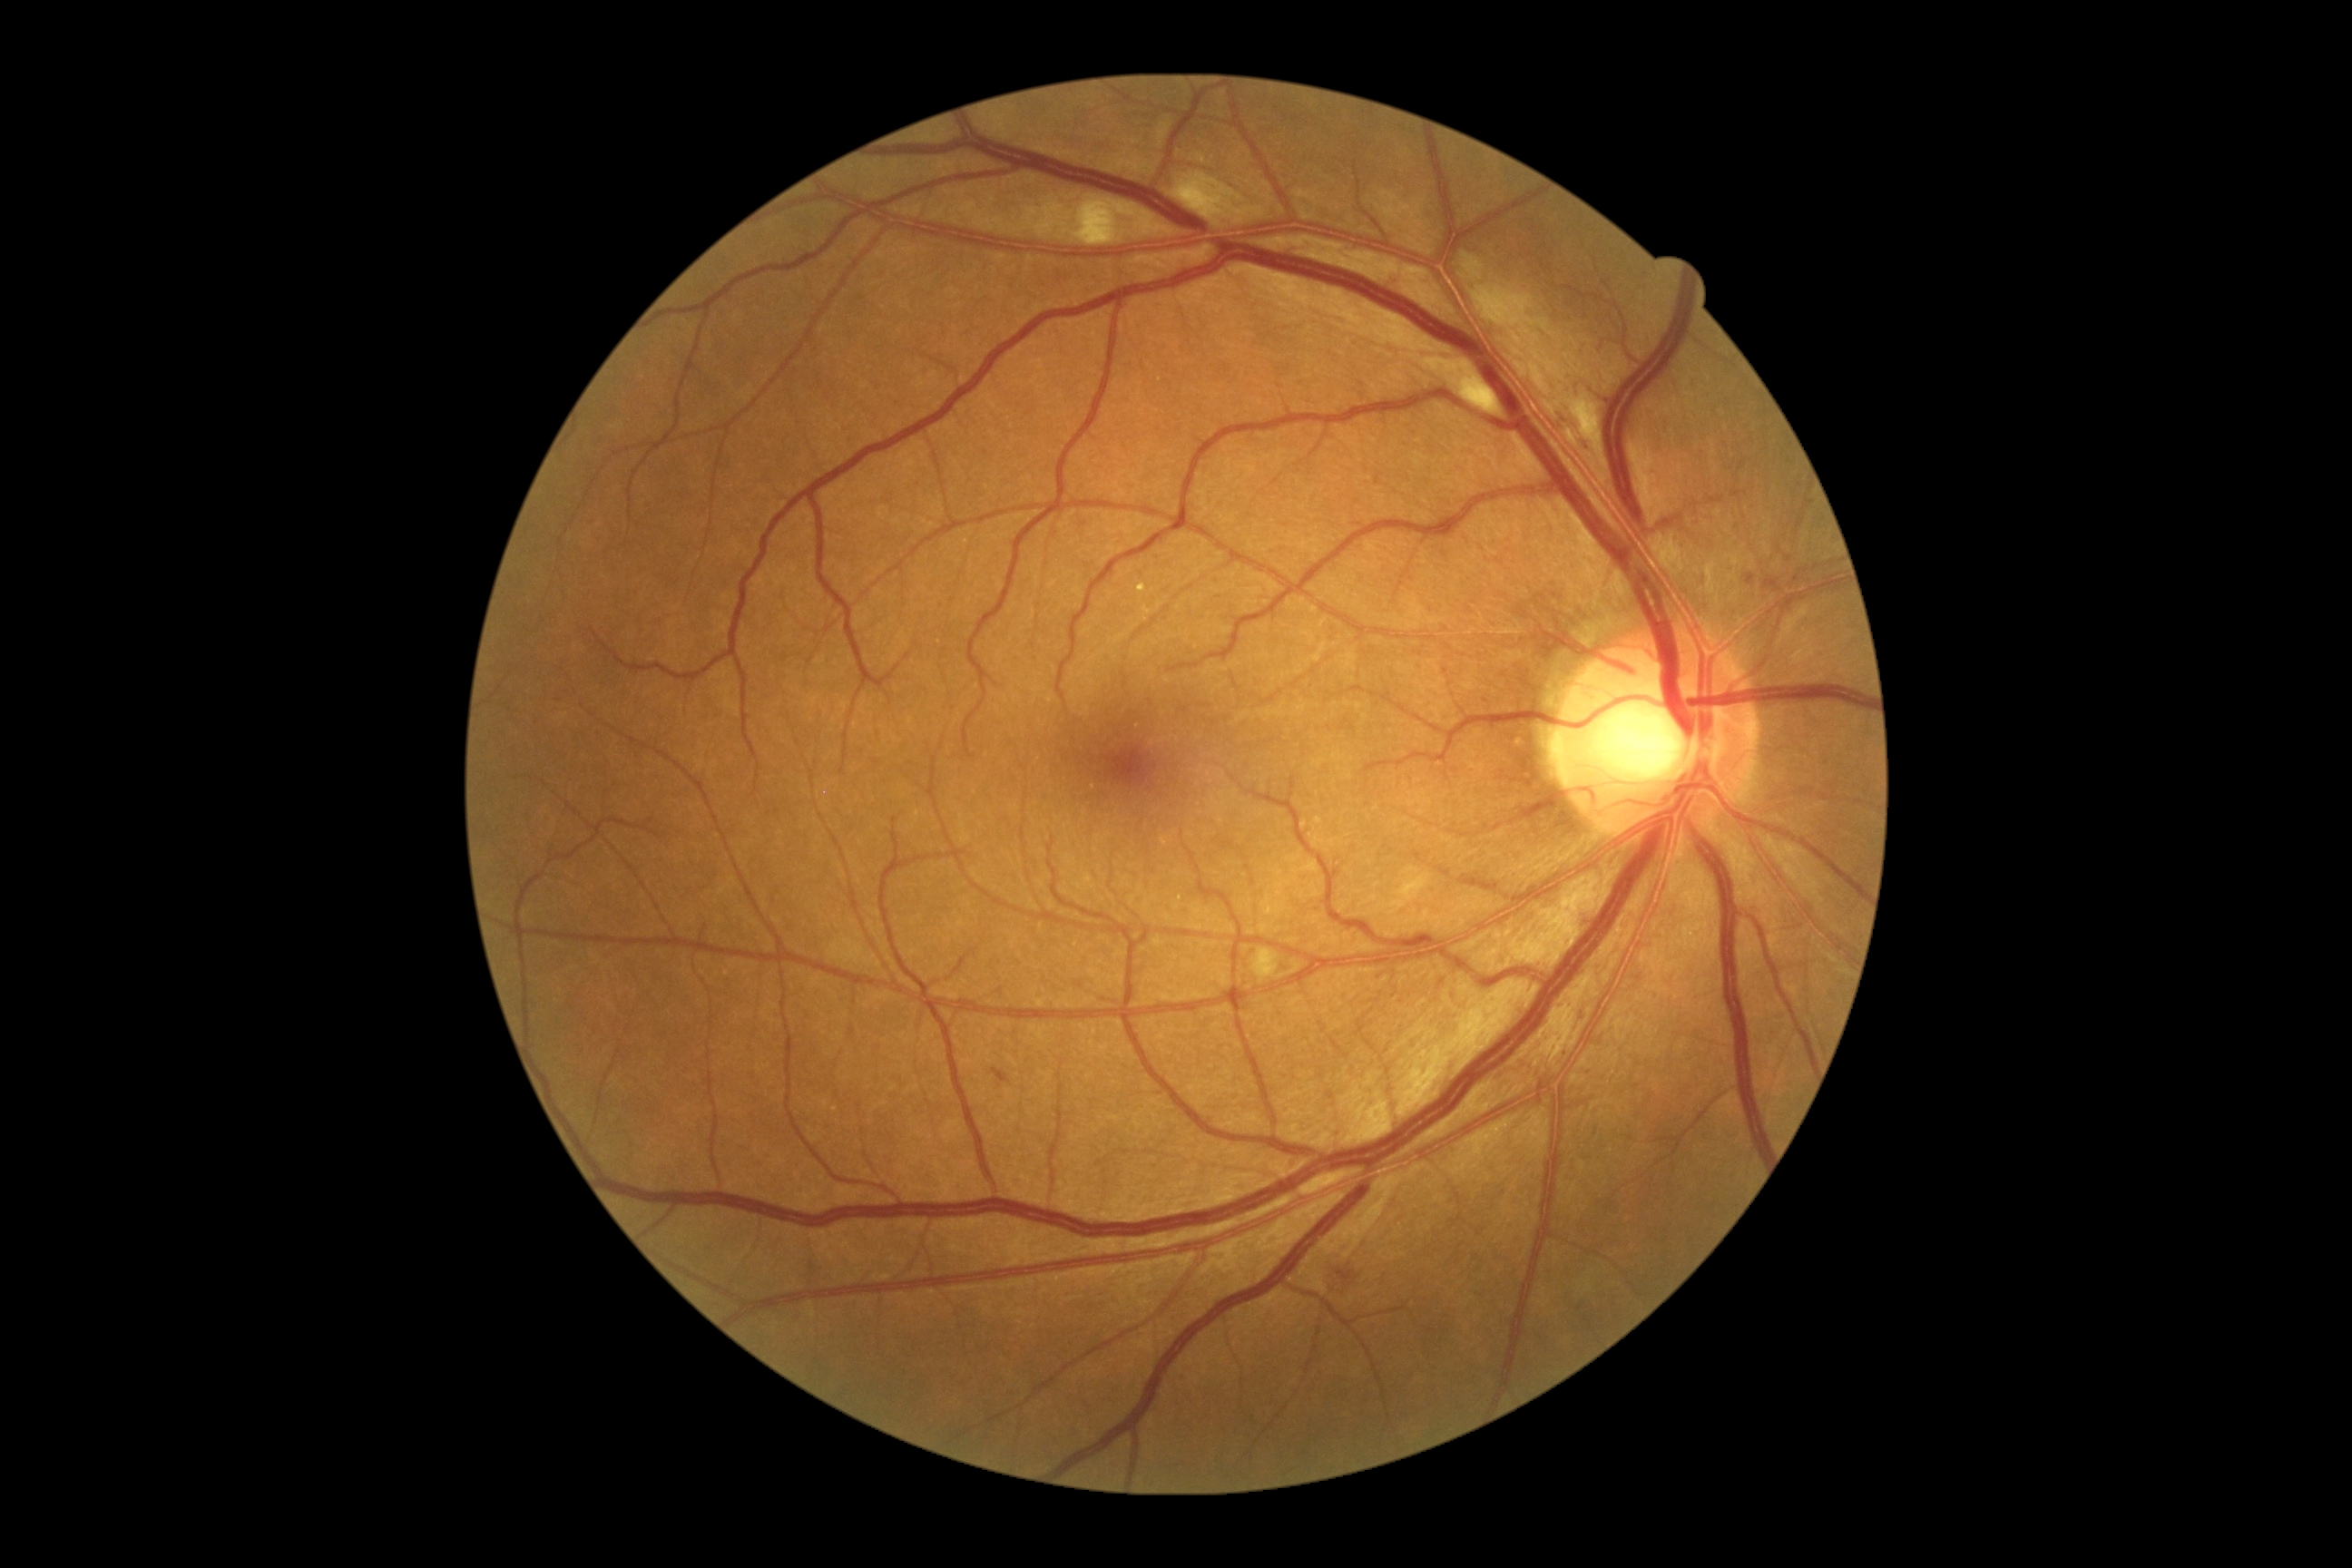

Diabetic retinopathy (DR): grade 2.